FOV: 45 degrees:
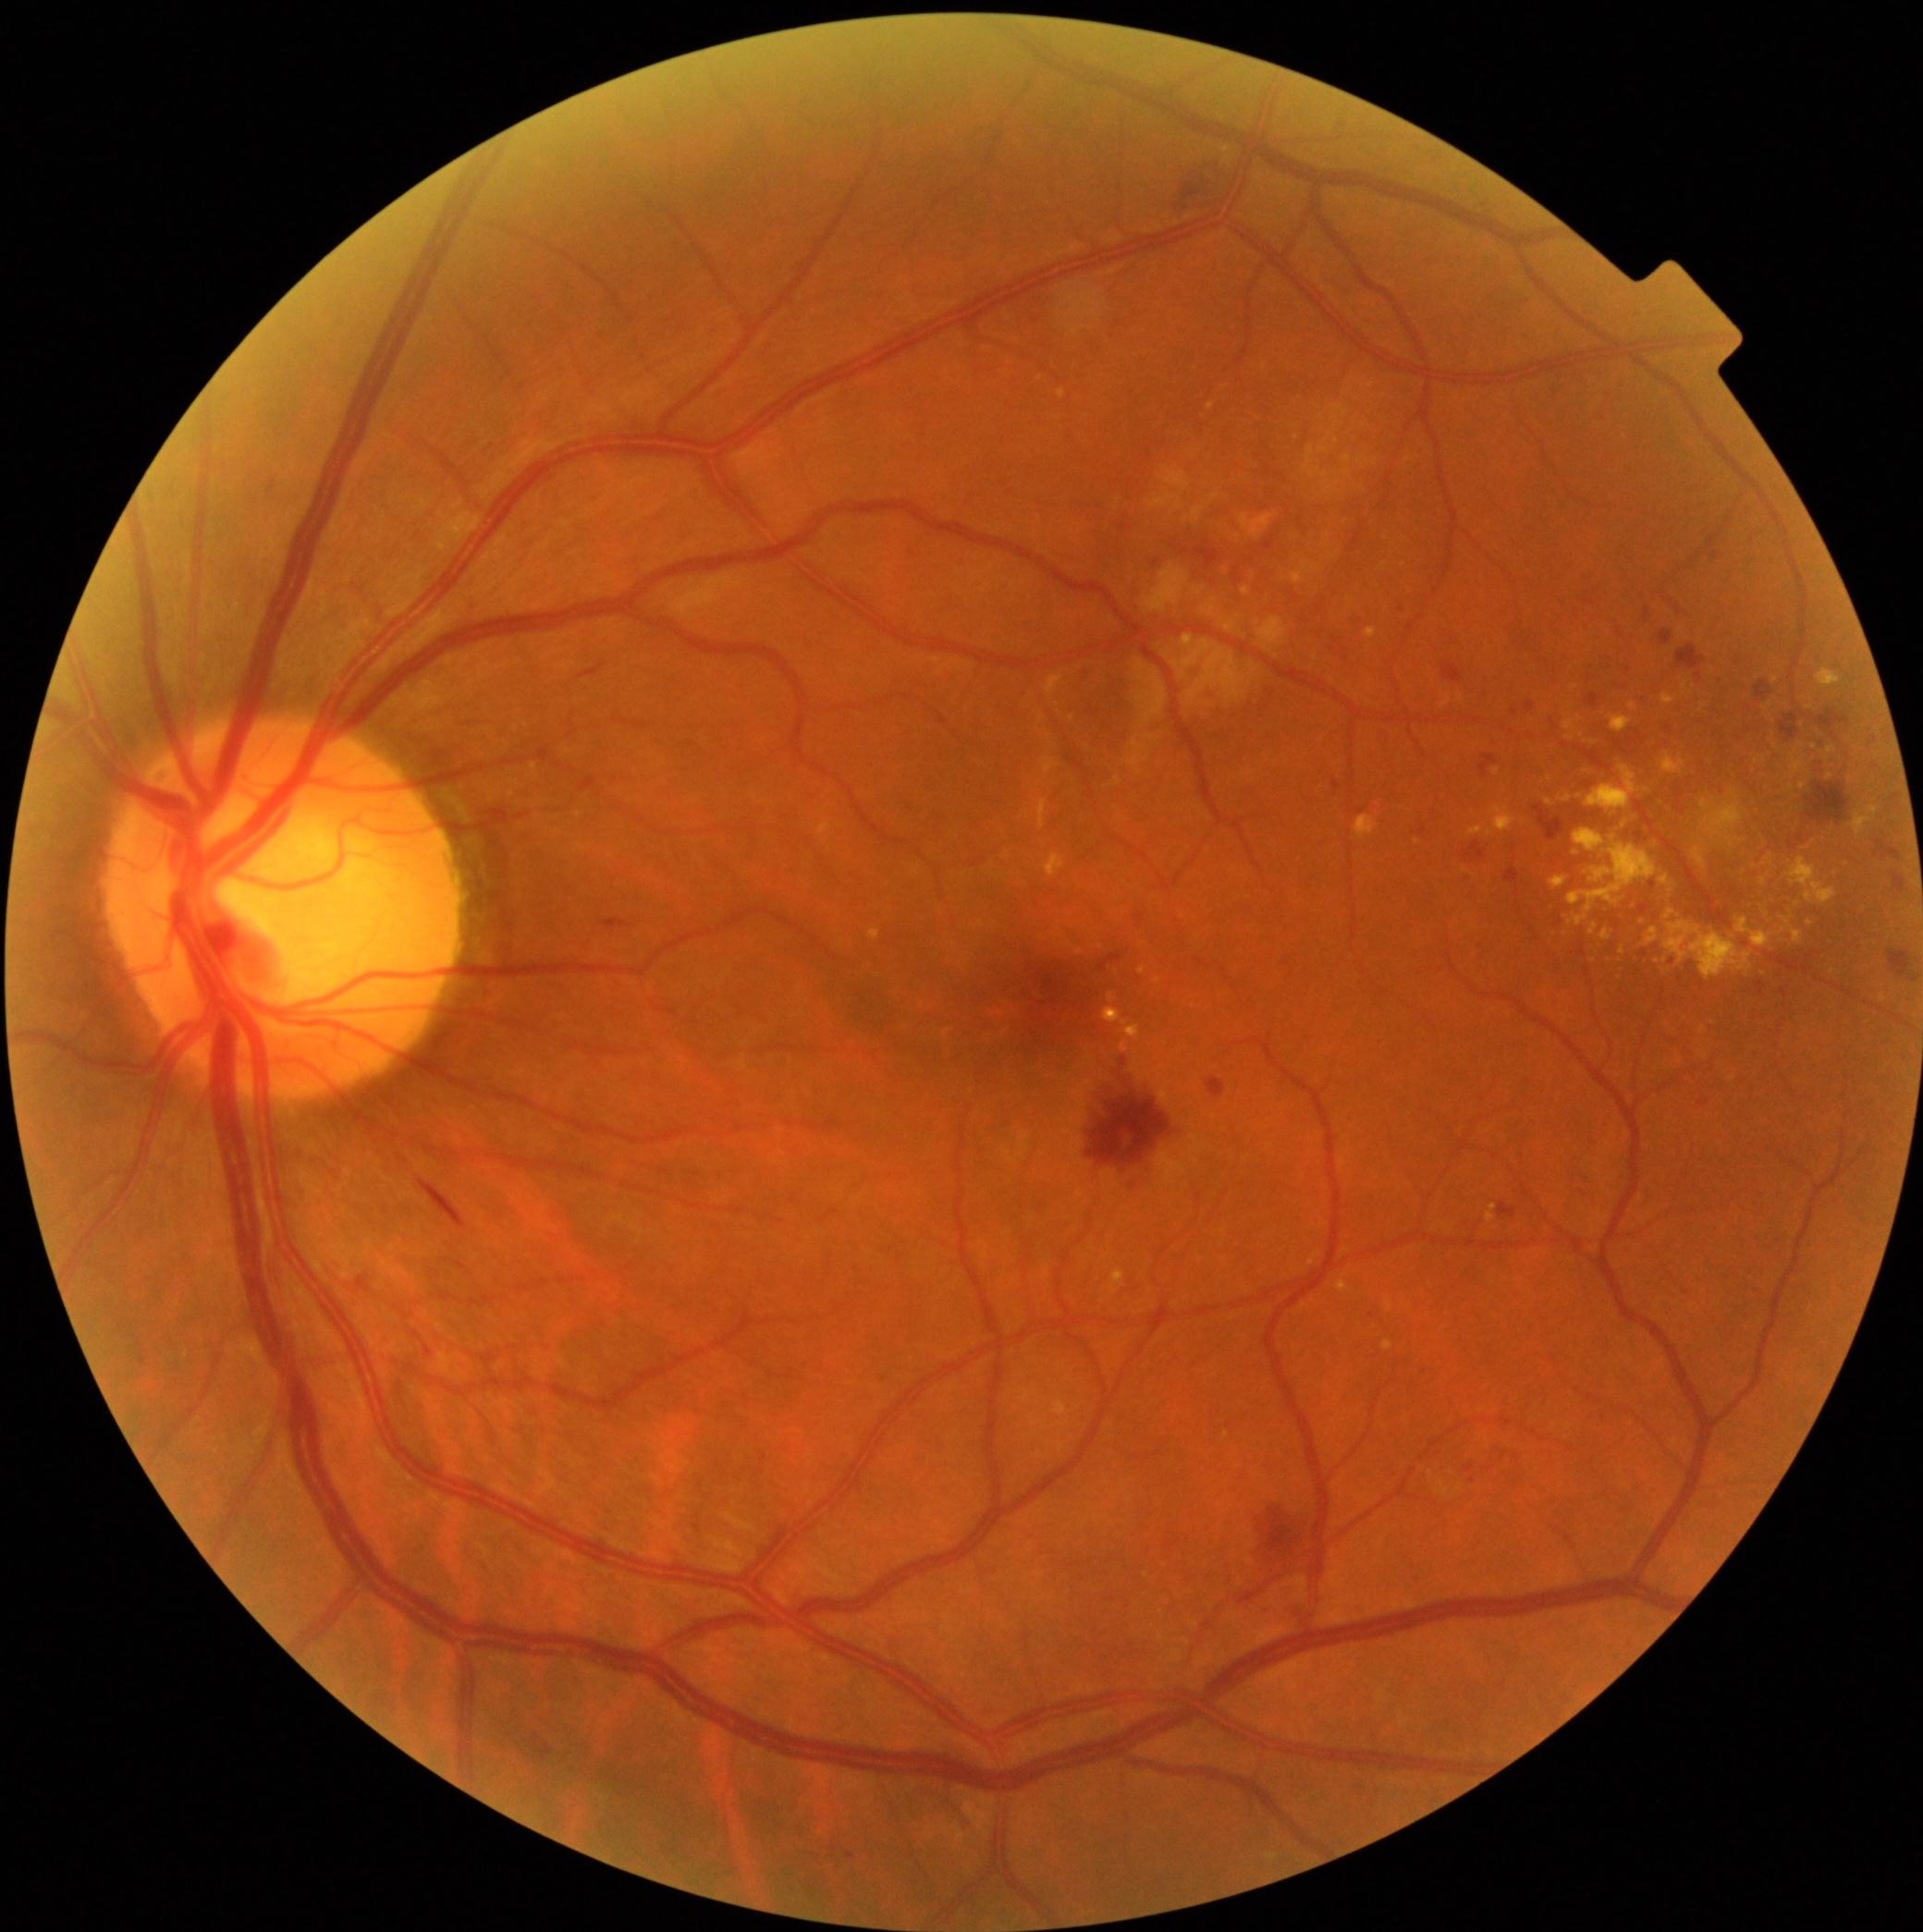

{"partial":true,"dr_grade":2,"lesions":{"ex":[[818,824,833,837],[1043,855,1065,878],[1621,948,1626,957],[1566,735,1574,741],[1337,1280,1349,1294],[1647,928,1660,947],[1665,910,1676,921],[1495,807,1517,833],[1663,694,1676,705],[1782,917,1791,926],[1110,1271,1125,1296],[1705,791,1745,846],[1108,994,1116,1004]],"ex_small":[[1576,854],[1583,736],[1575,688],[1768,915],[1803,786],[1550,780]]}}